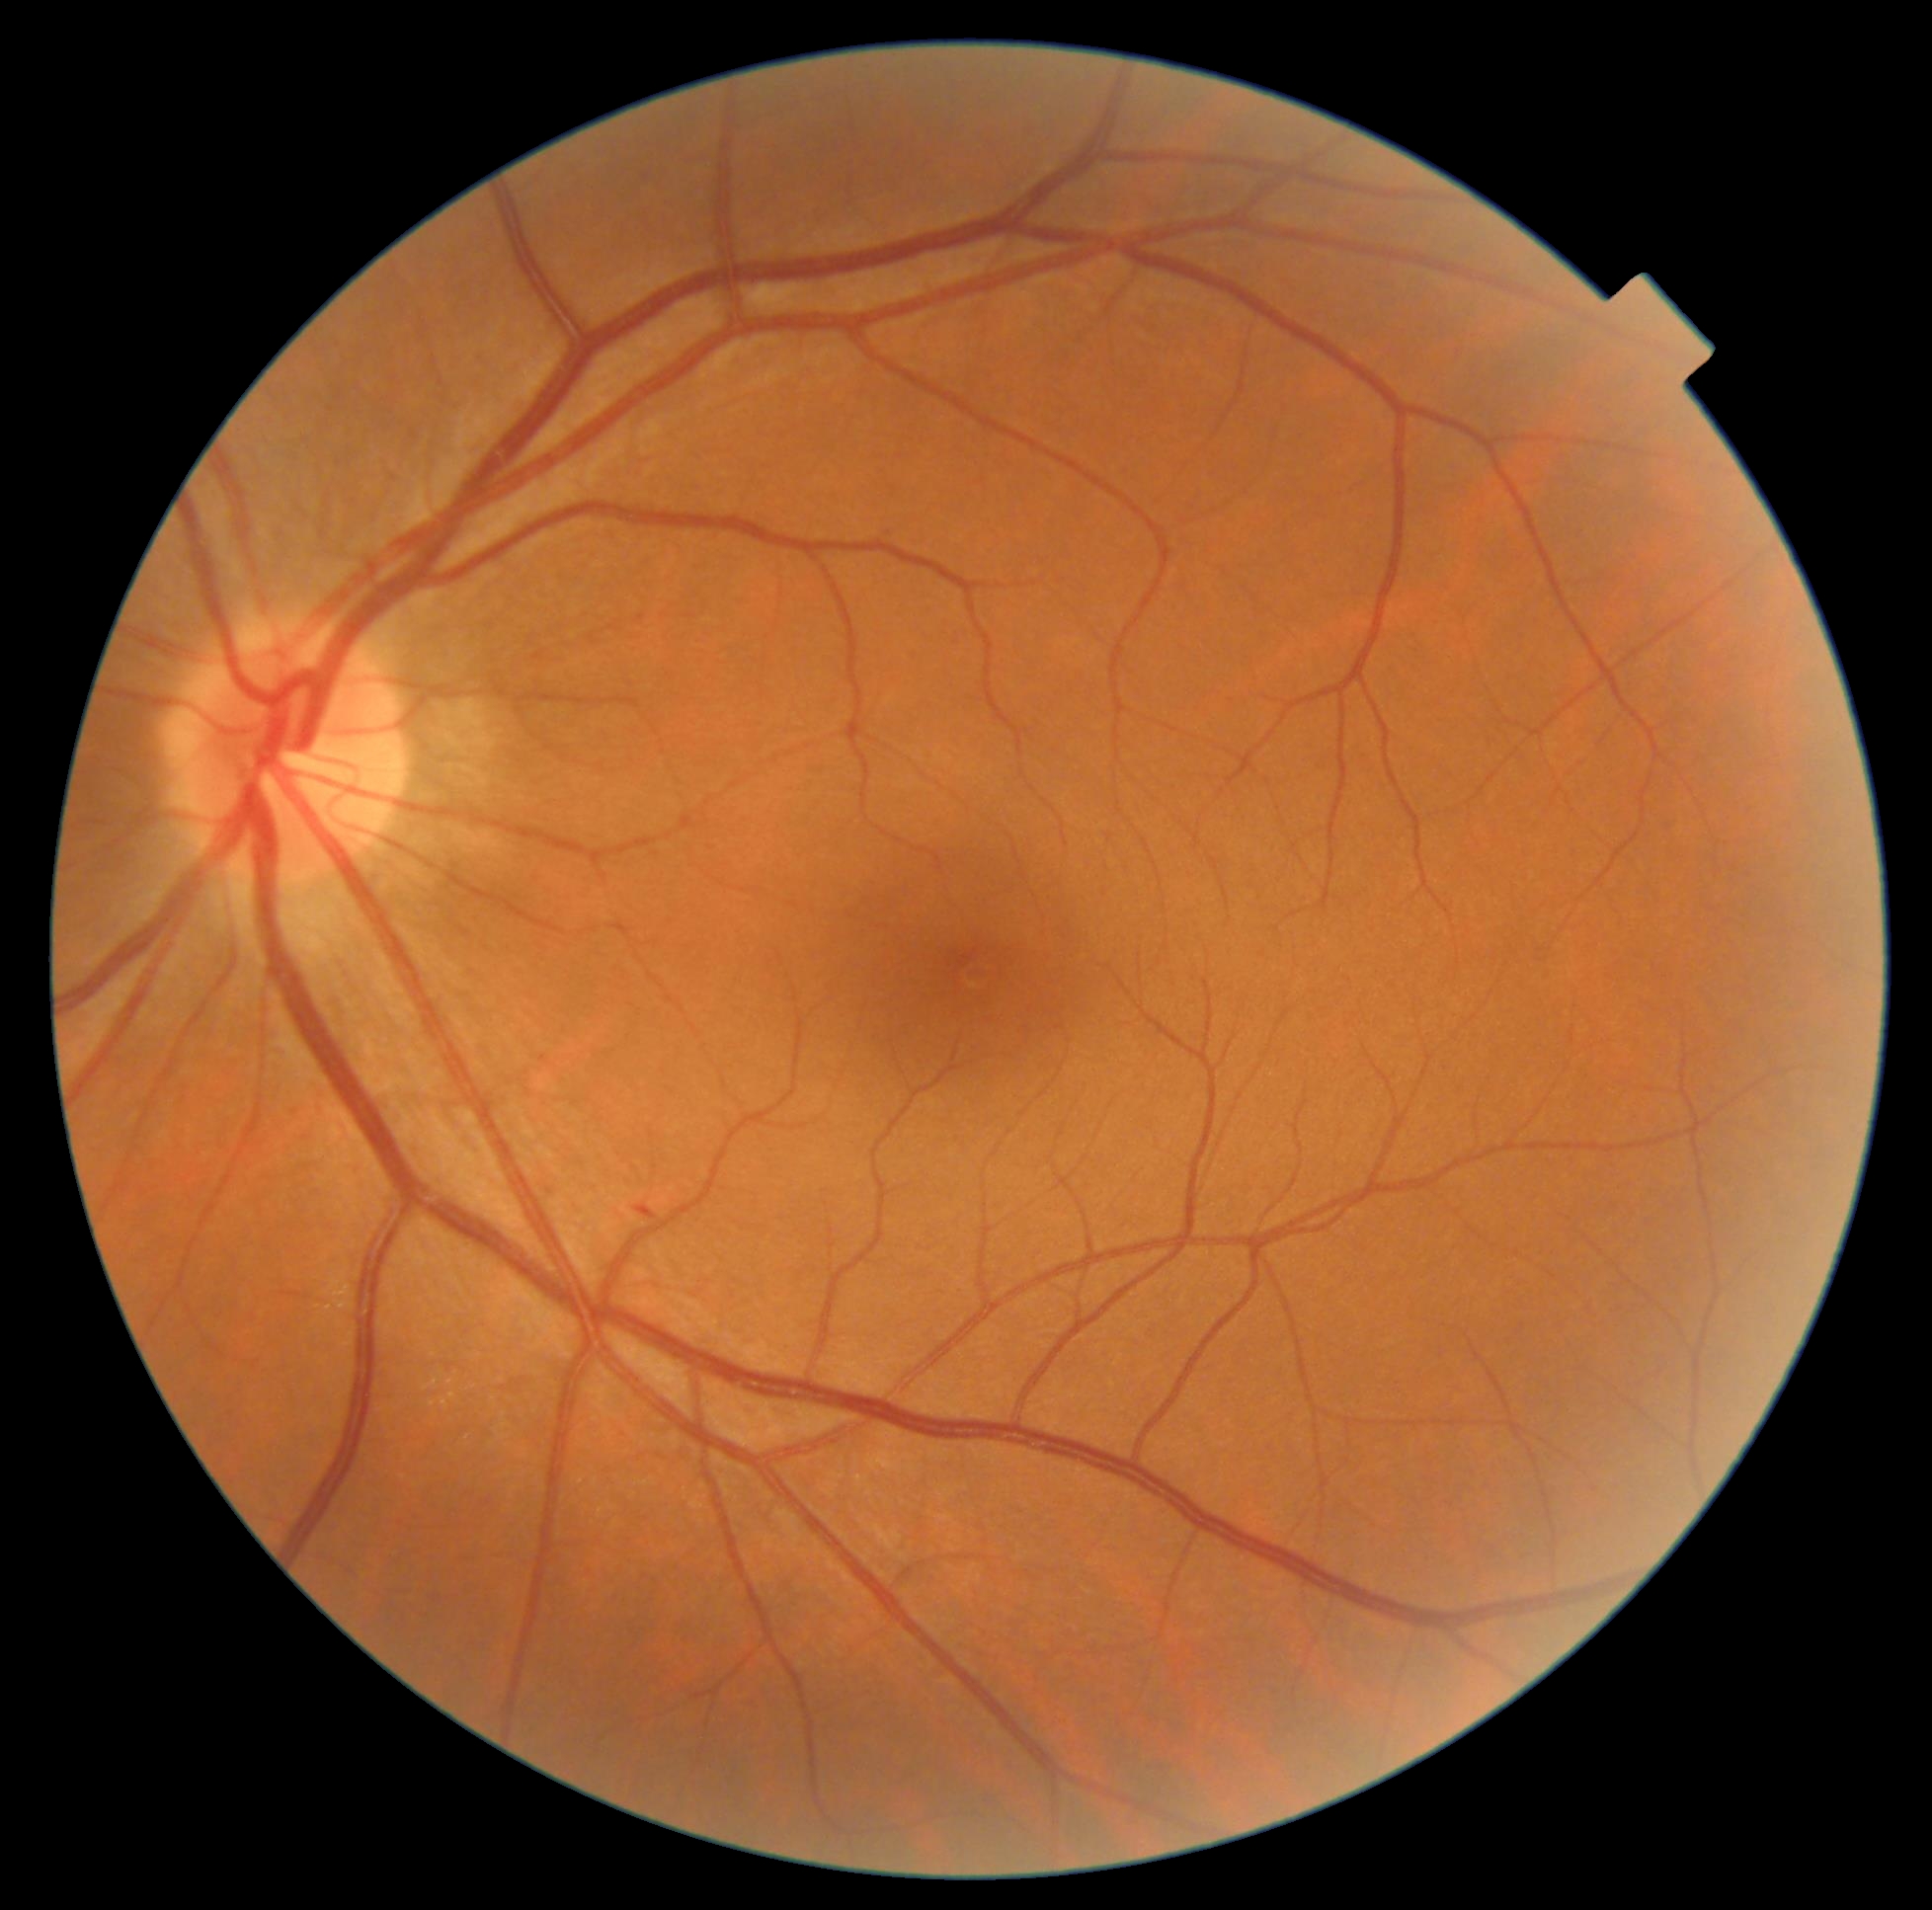
Diabetic retinopathy: 1/4.